Without pupil dilation · 45-degree field of view — 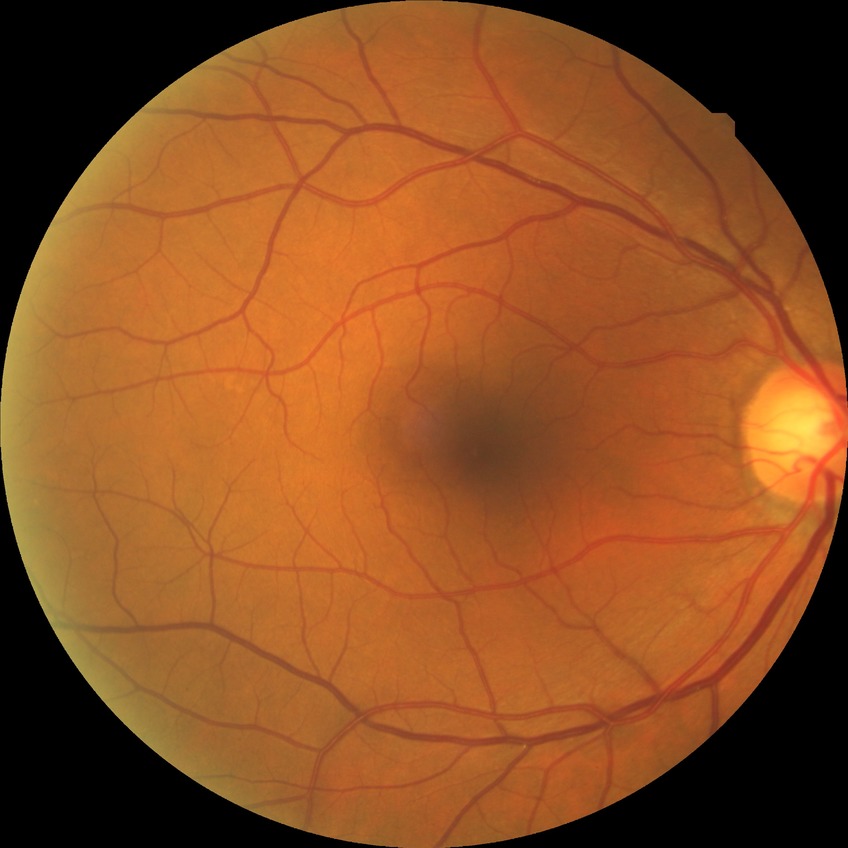
DR stage is NDR.